Image size 1536x1152
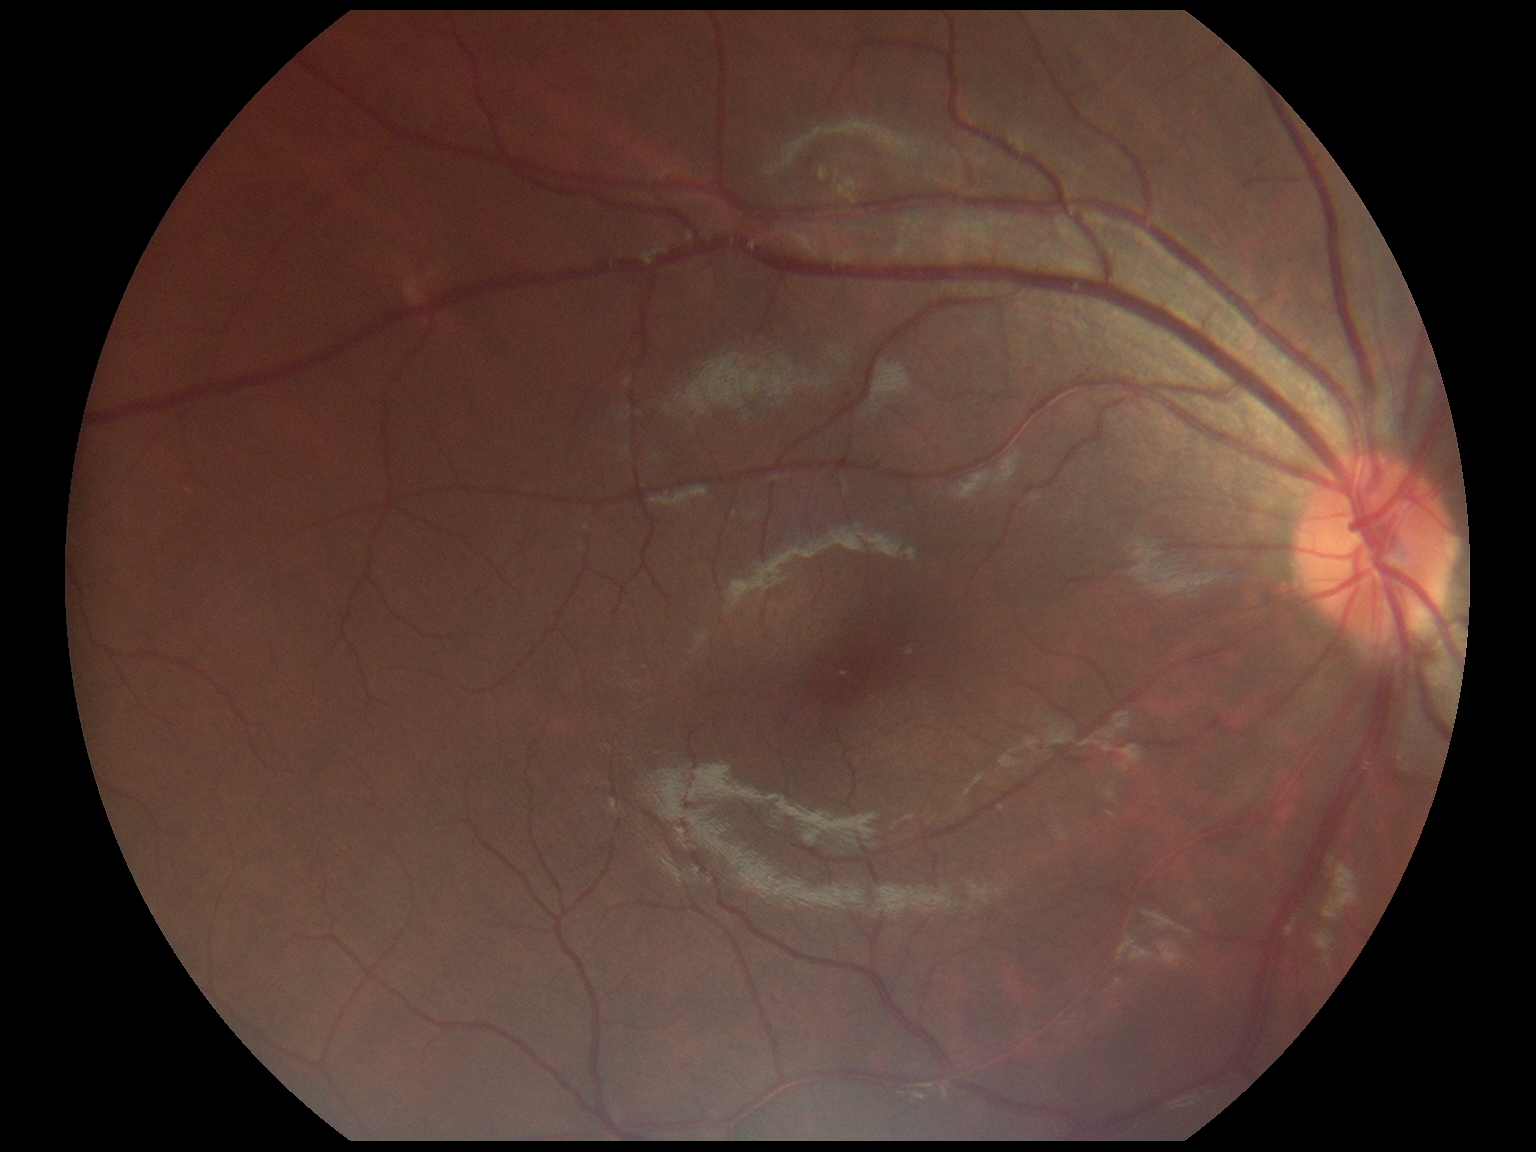
DR severity is grade 0.